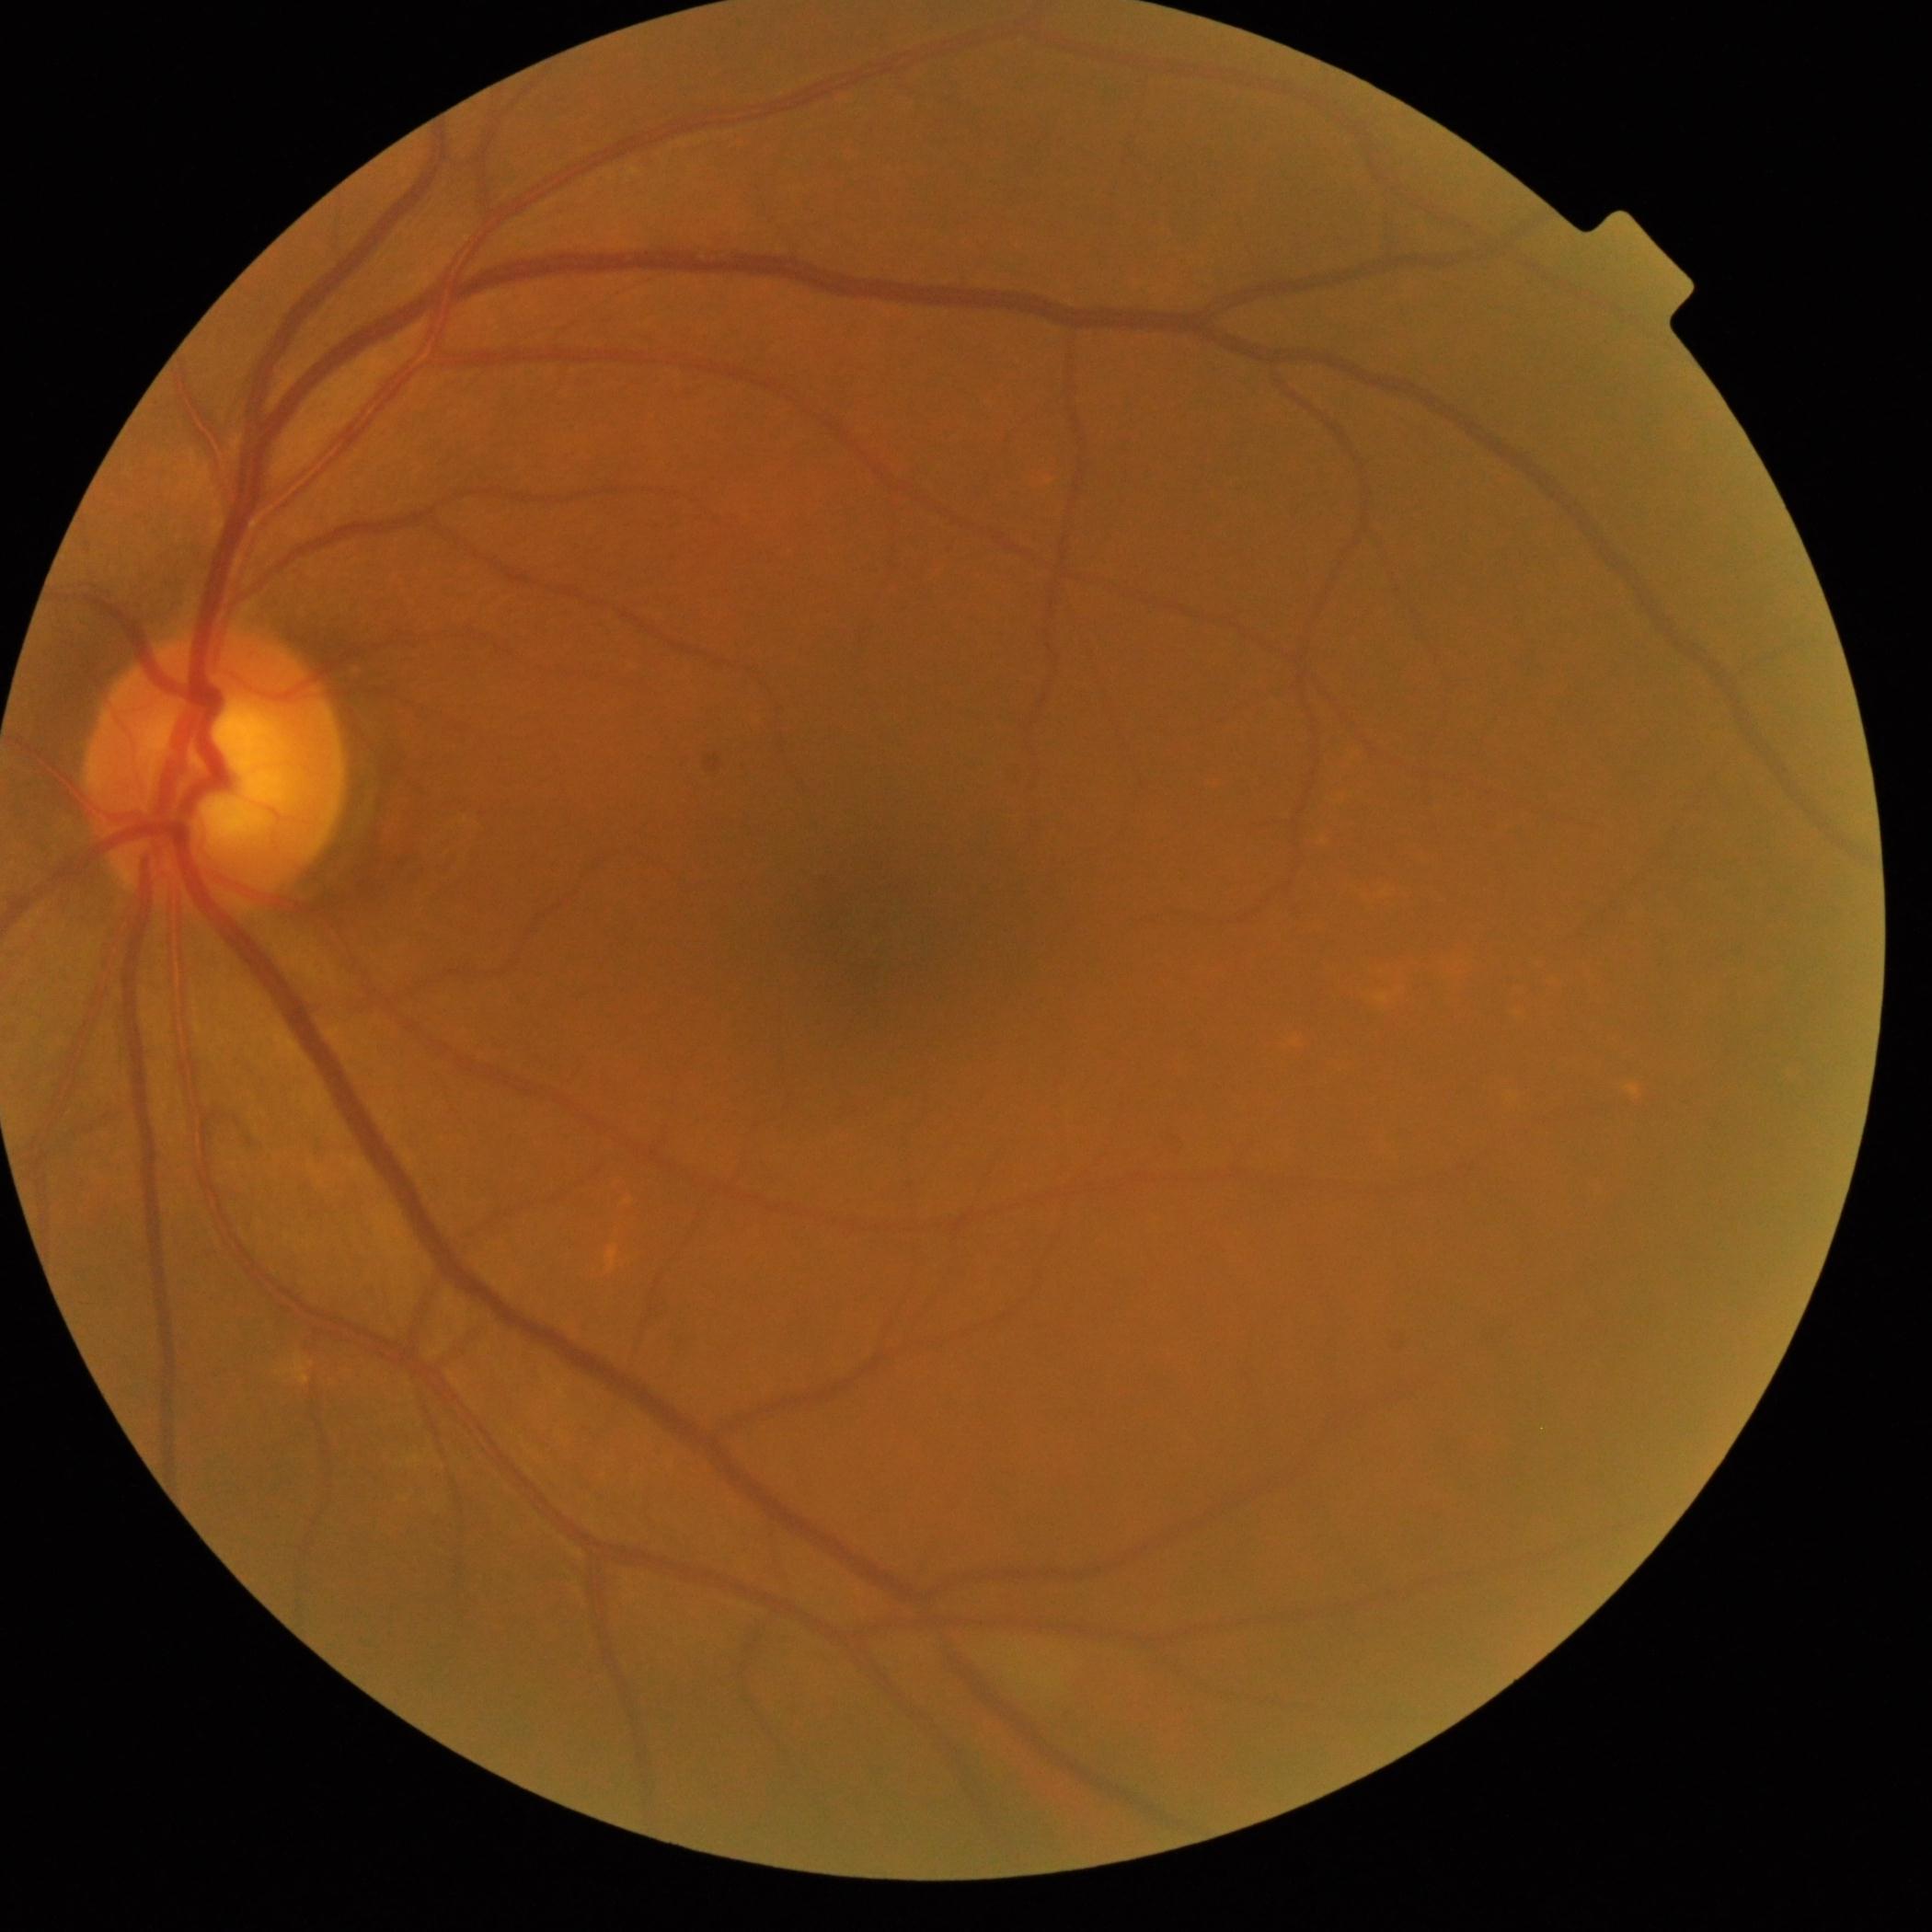 DR: grade 0.
No diabetic retinal disease findings.